2212 by 1659 pixels. Retinal fundus photograph — 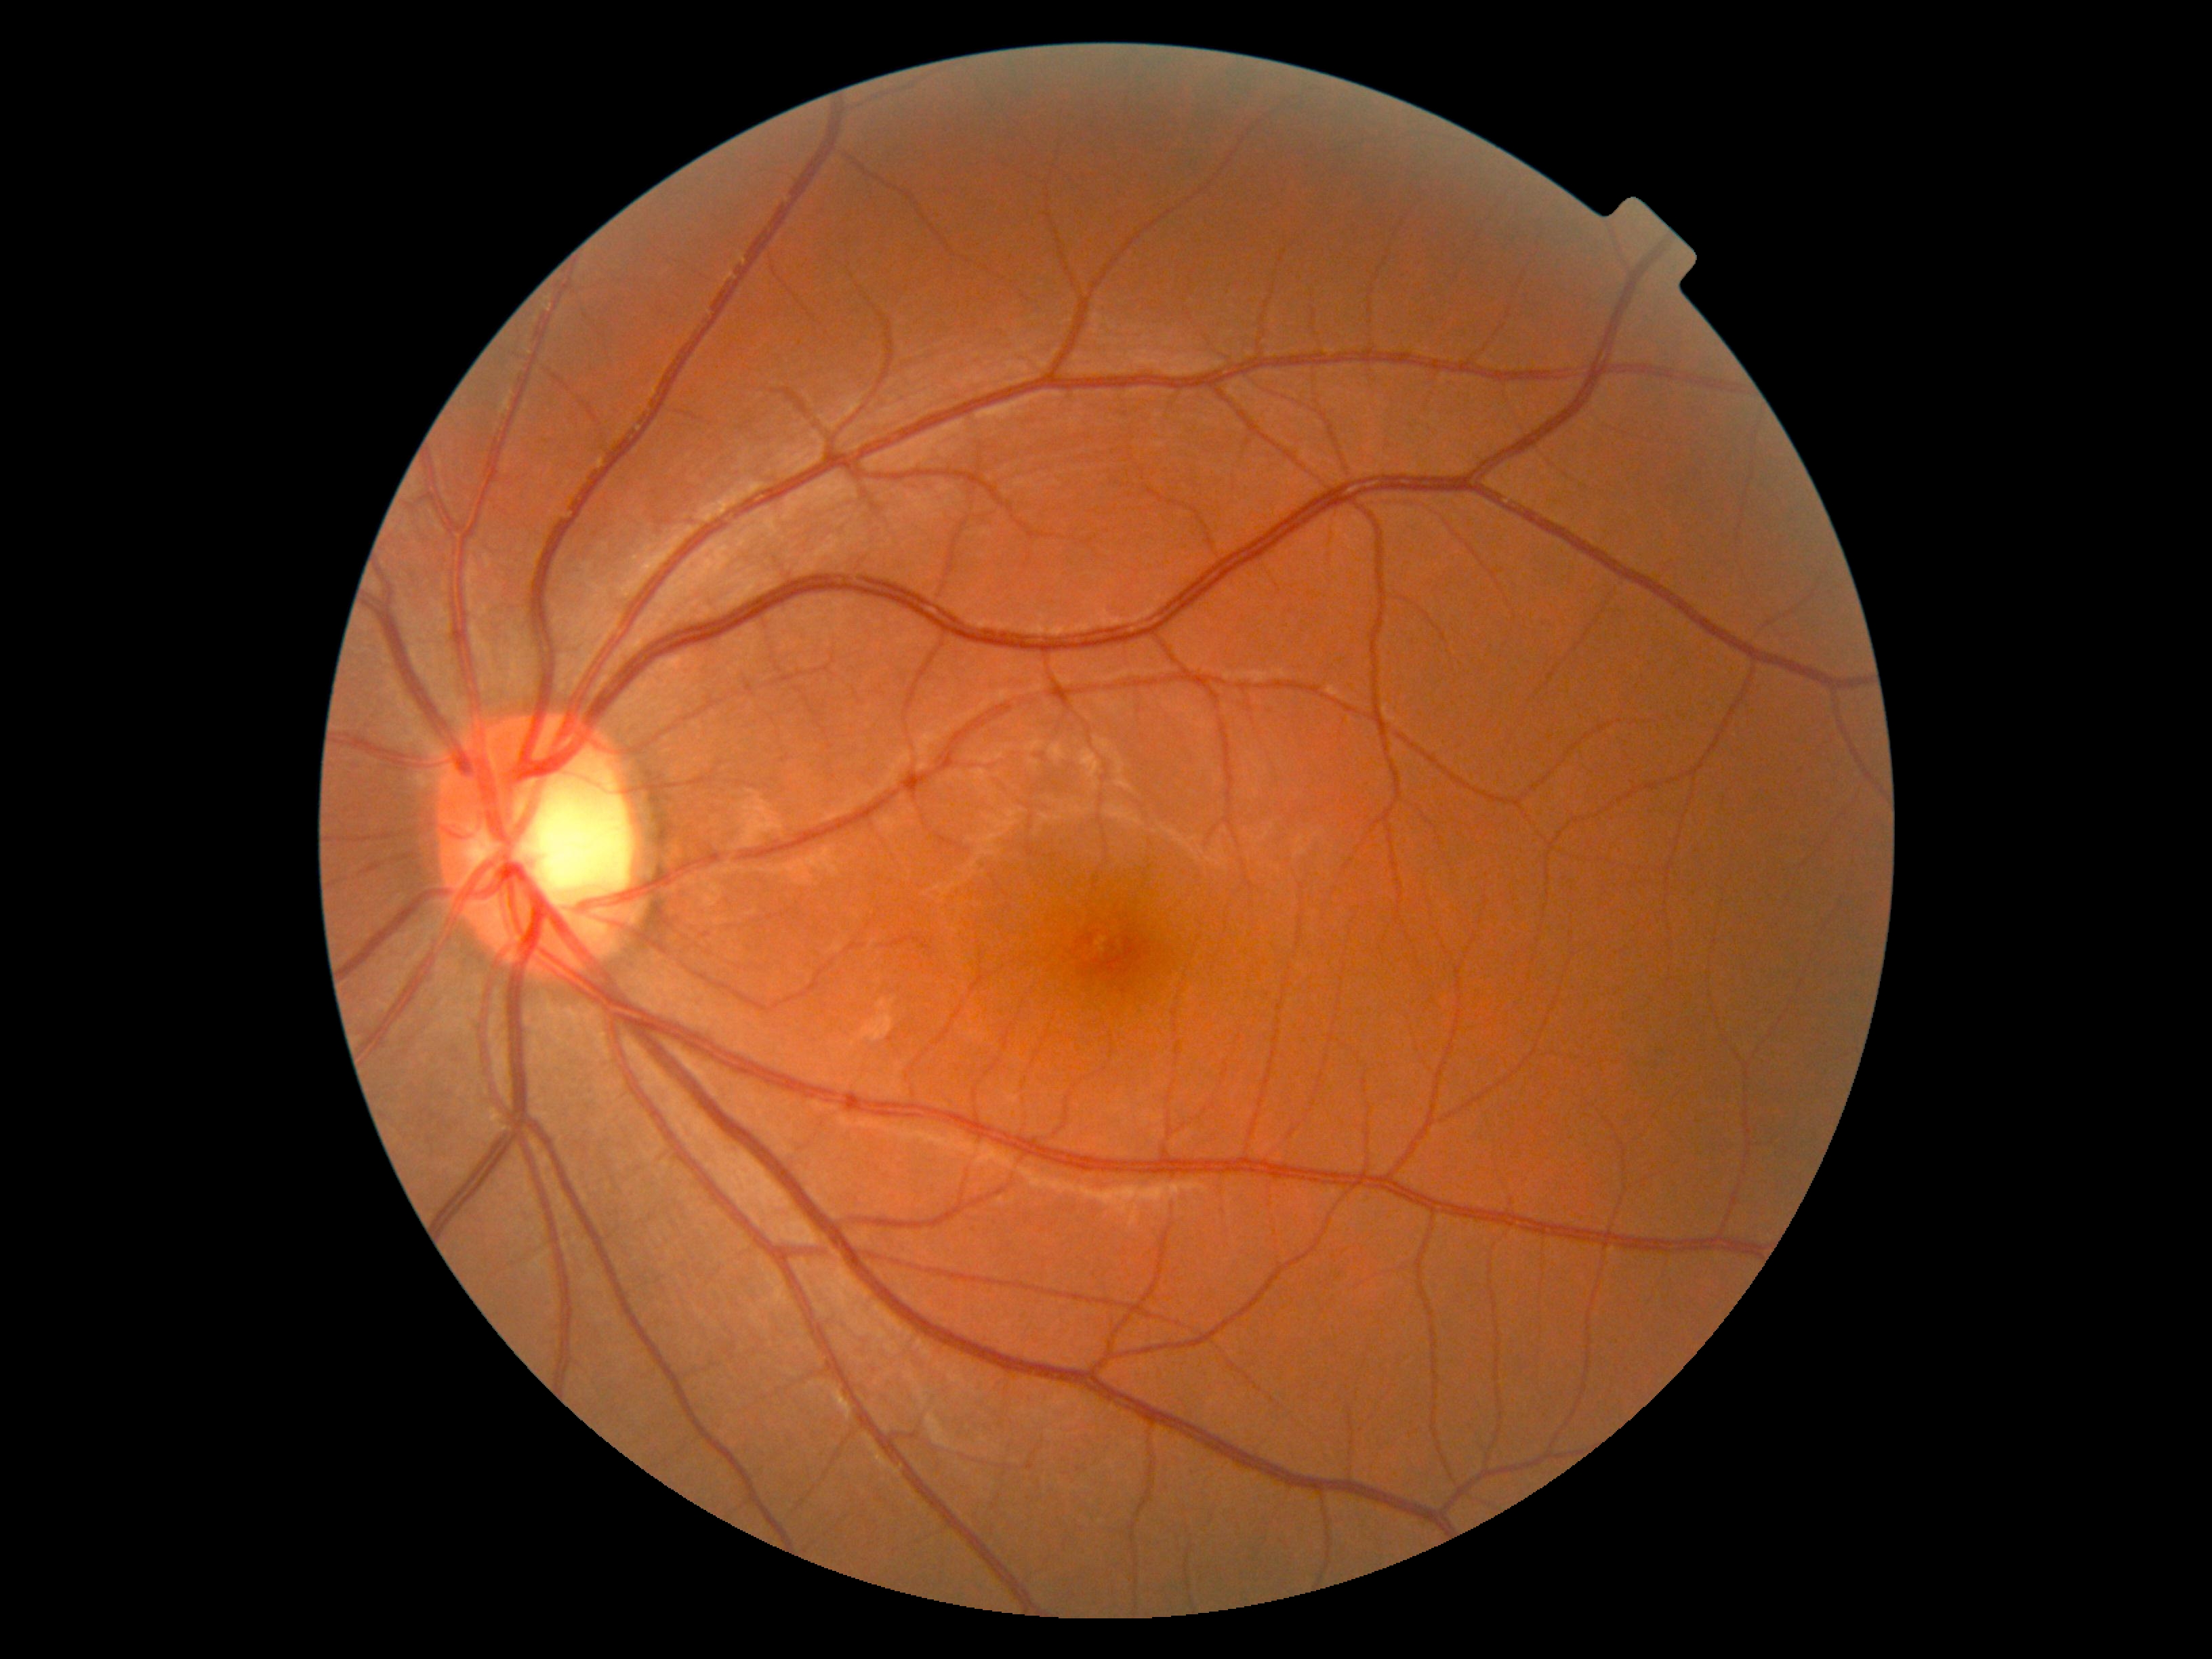 diabetic retinopathy severity = grade 0 (no apparent retinopathy), DR impression = no signs of DR.